Captured after pupil dilation. 50-degree field of view — 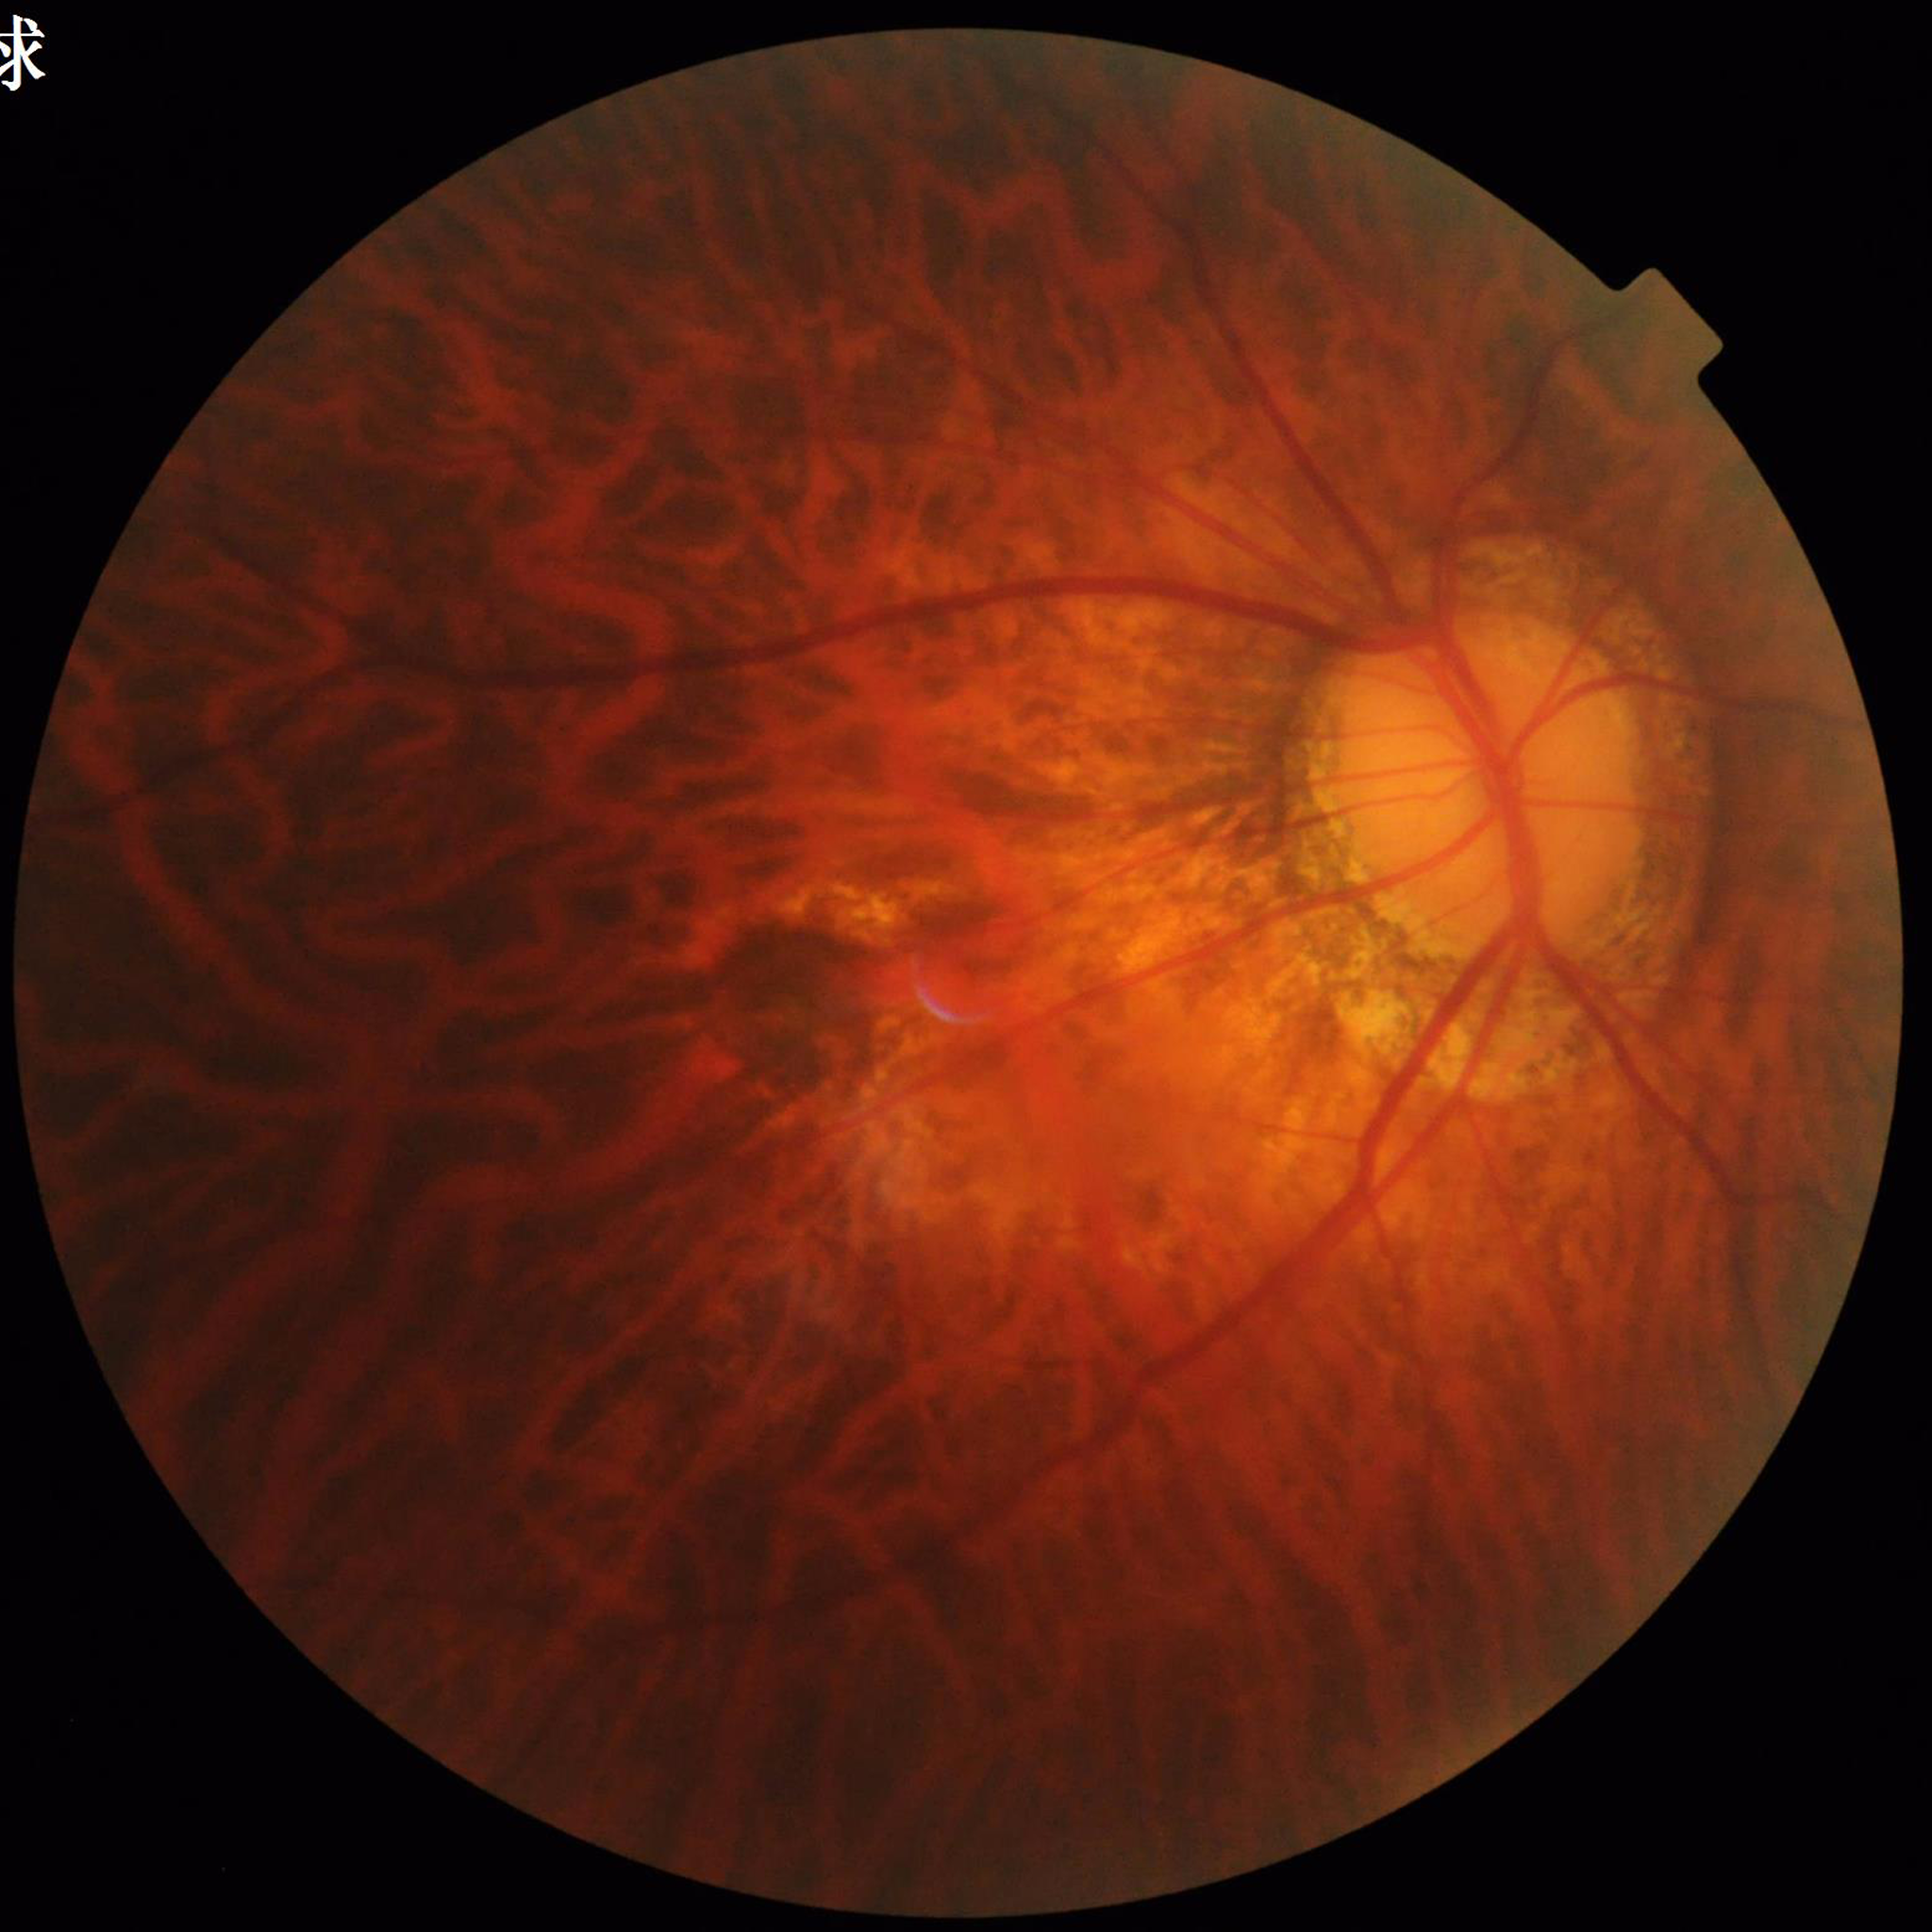 From a patient with age-related macular degeneration. Automated quality assessment: no blur, illumination/color distortion present, contrast adequate.